Image size 2352x1568; FOV: 45 degrees; retinal fundus photograph: 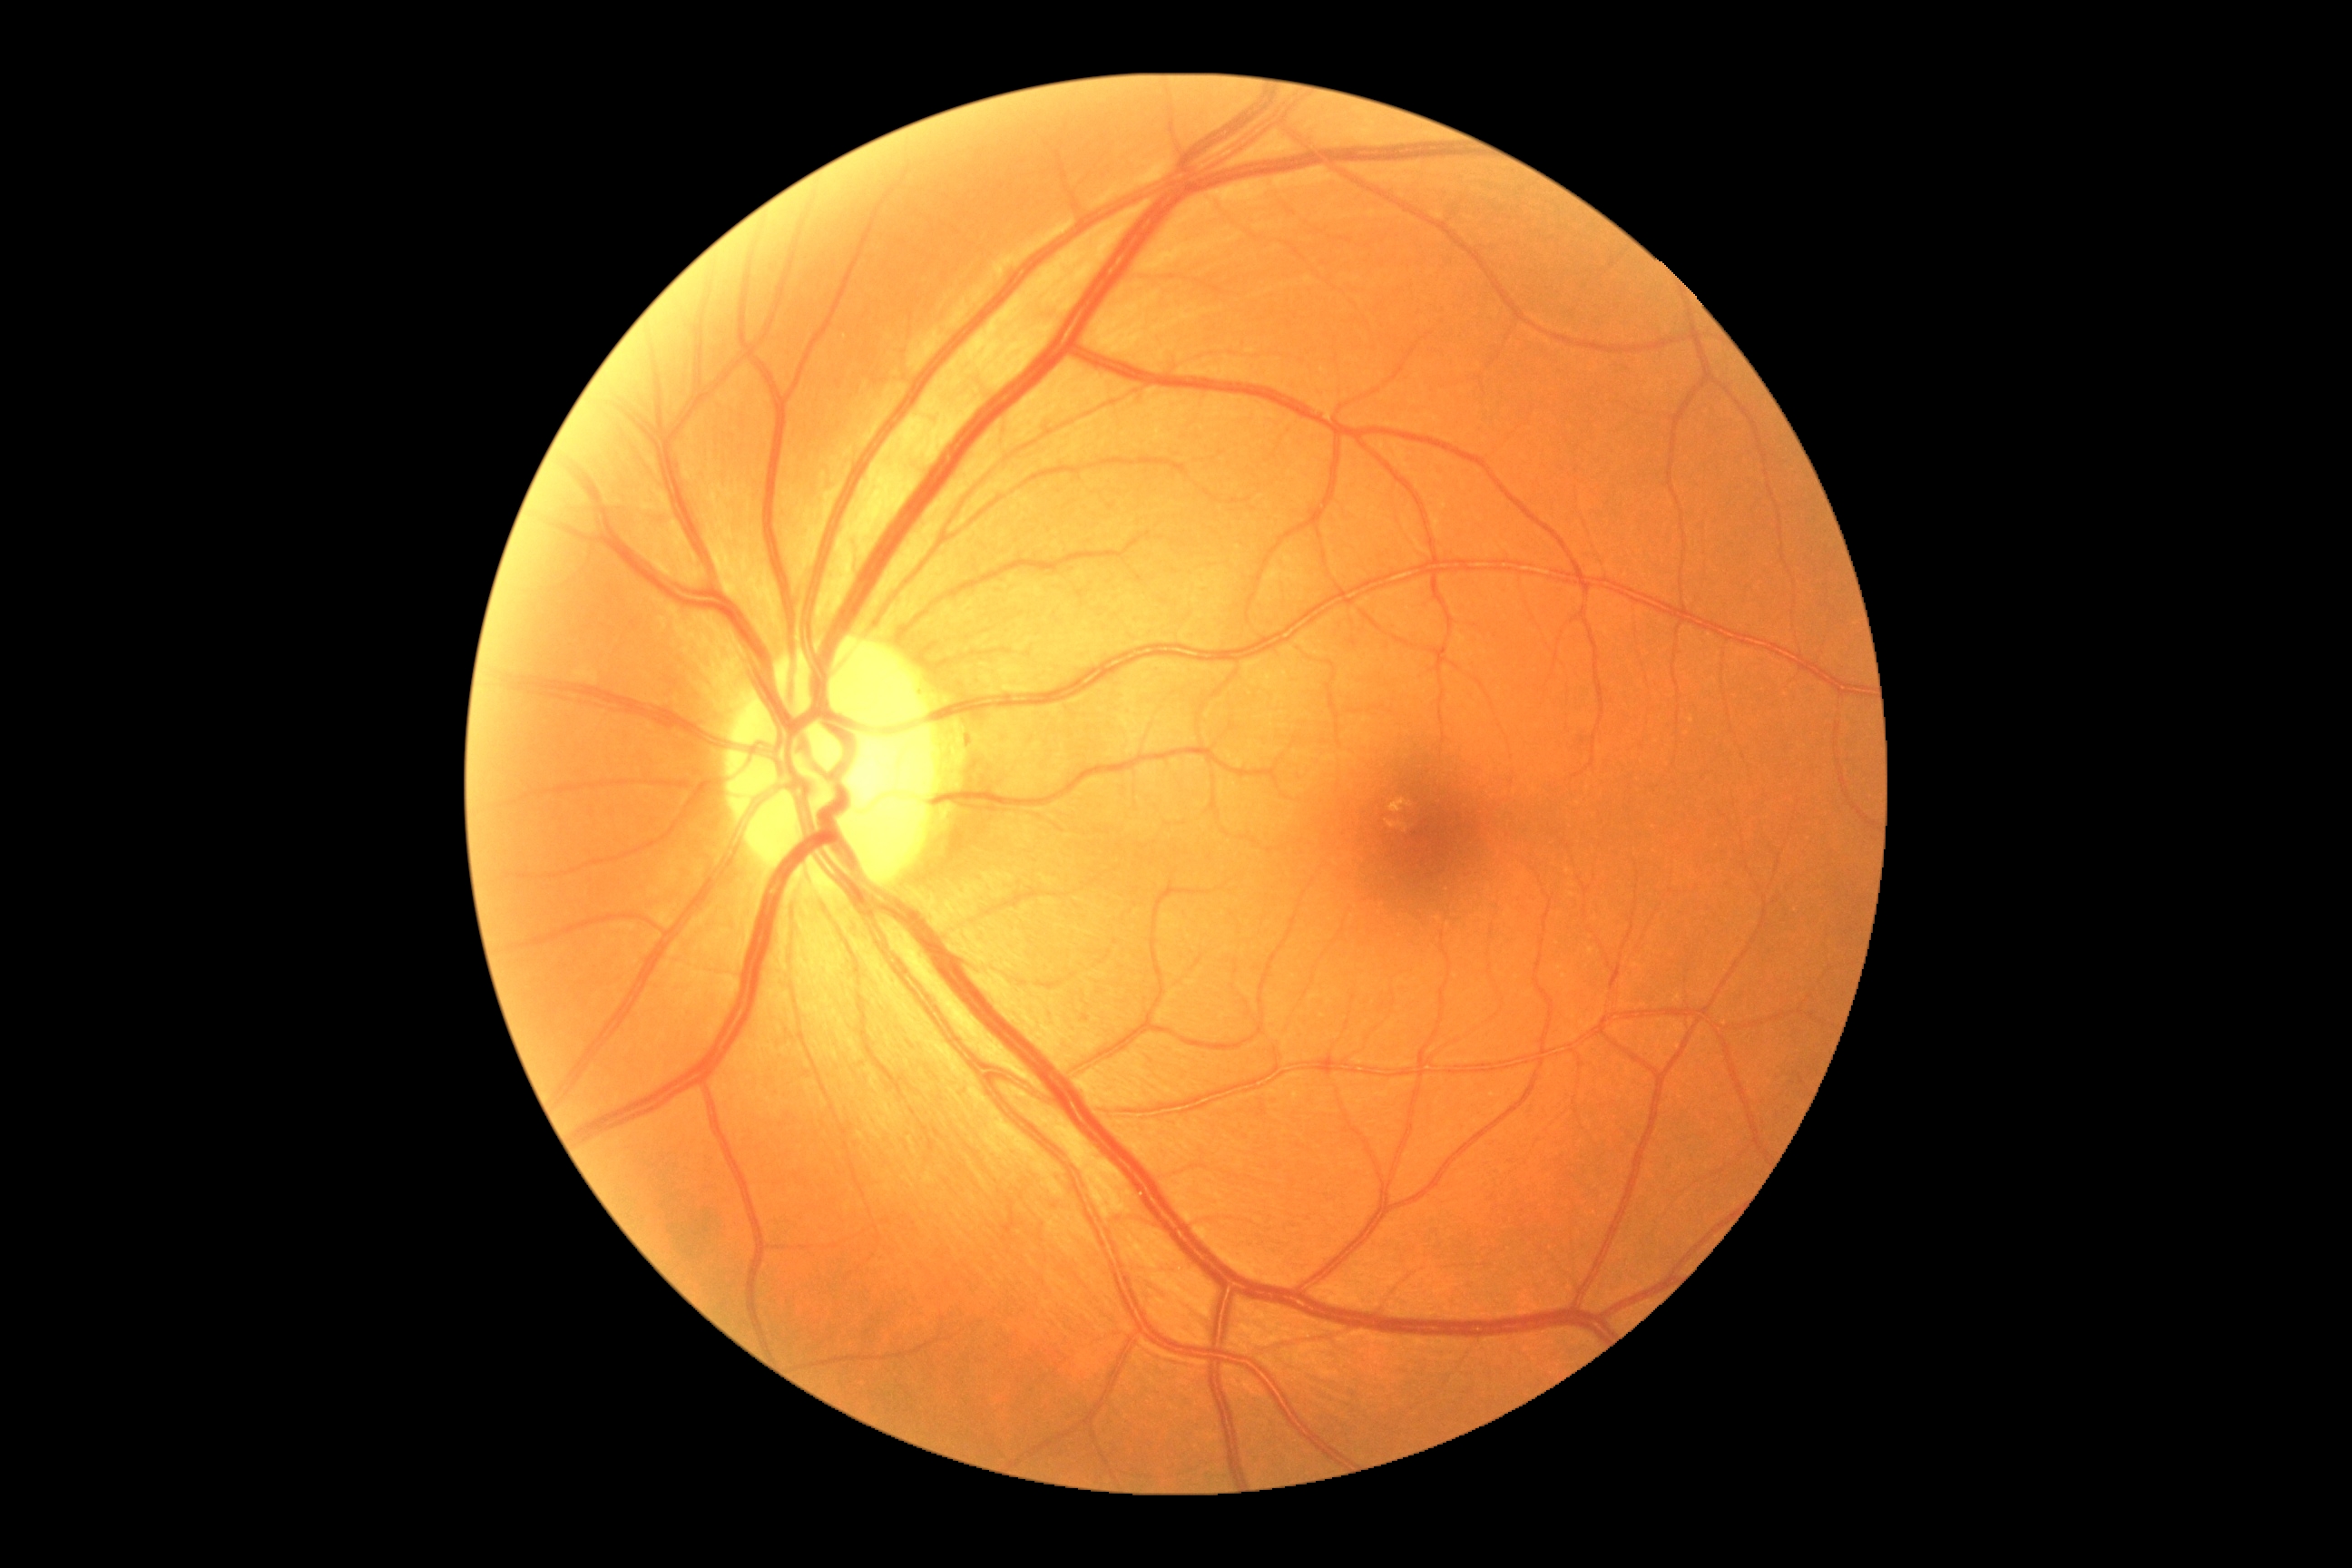
DR: no apparent retinopathy (grade 0) — no visible signs of diabetic retinopathy.